Infant wide-field retinal image; acquired on the Clarity RetCam 3.
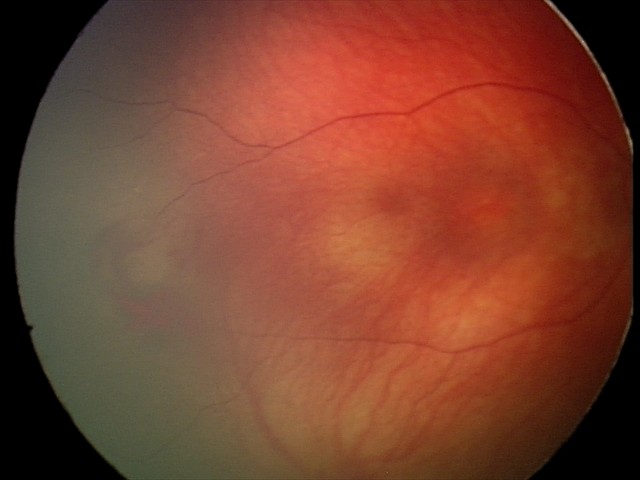

Screening series with retinal hemorrhages.